DR severity per modified Davis staging
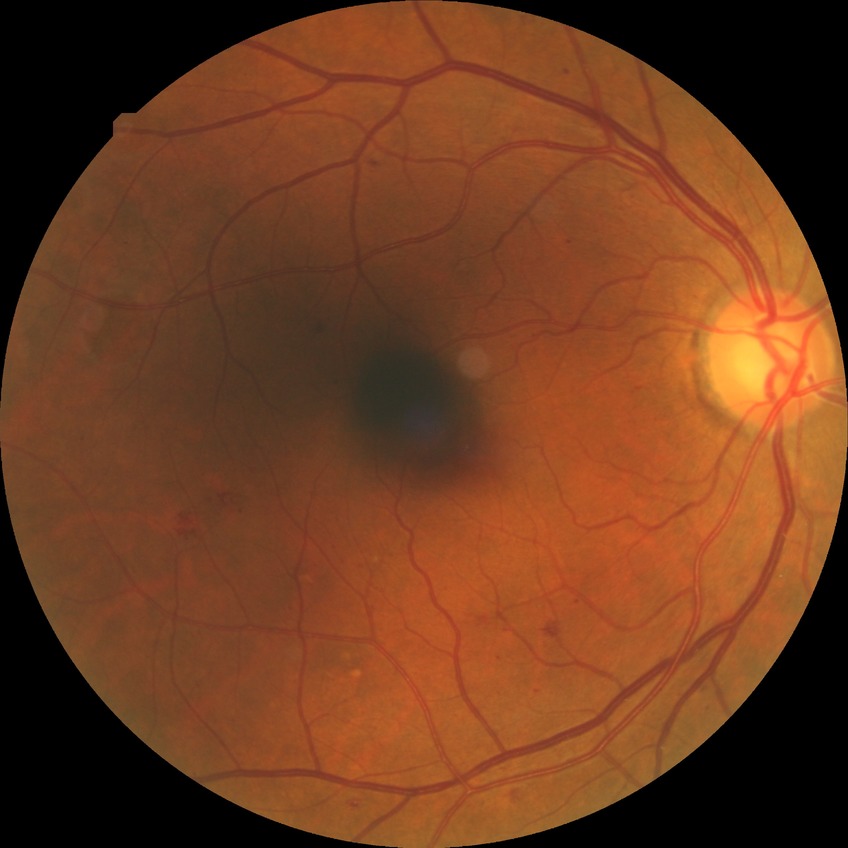

DR=SDR.